240x240. Nidek AFC-330:
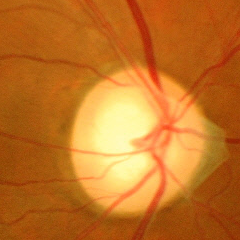

Impression = advanced glaucoma.